45° field of view; color fundus photograph
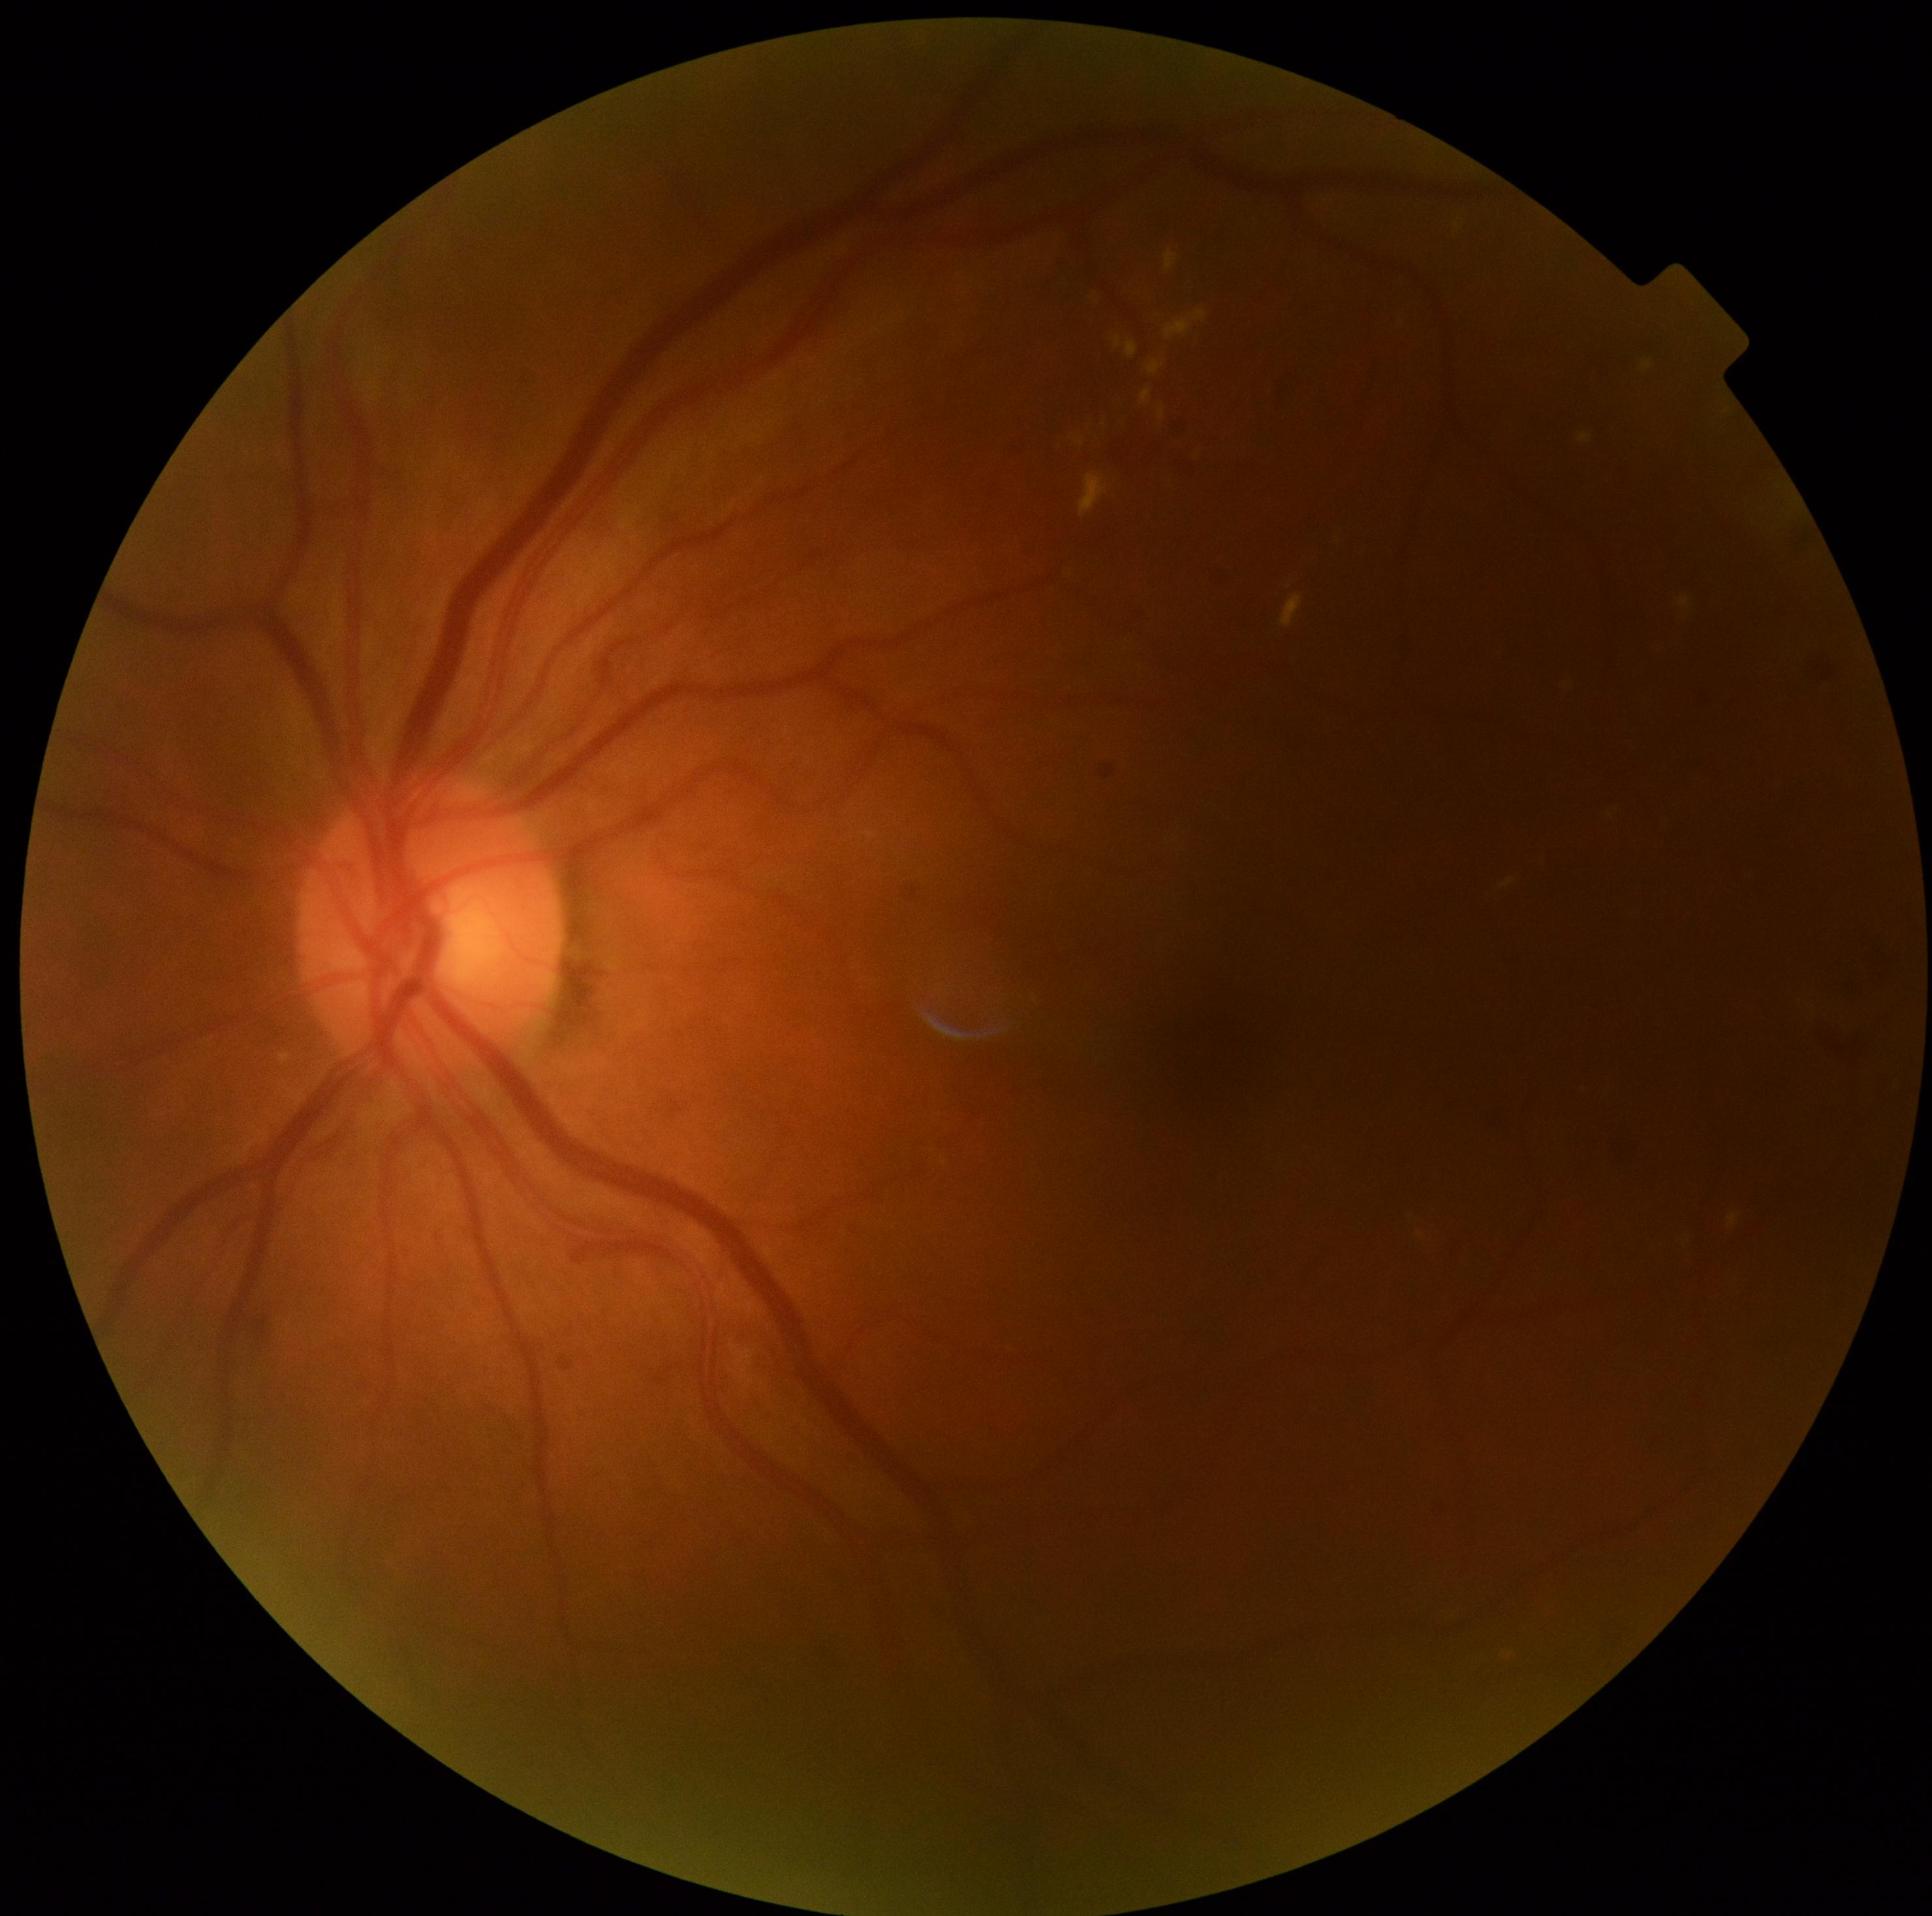   dr_grade: 2